Infant wide-field fundus photograph.
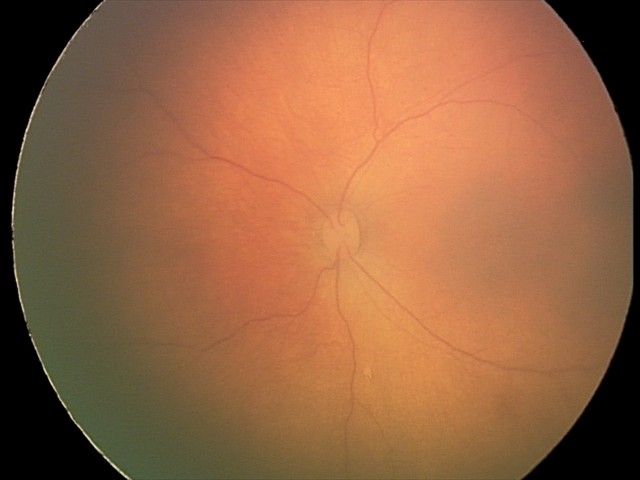

Q: What was the screening finding?
A: no abnormal retinal findings